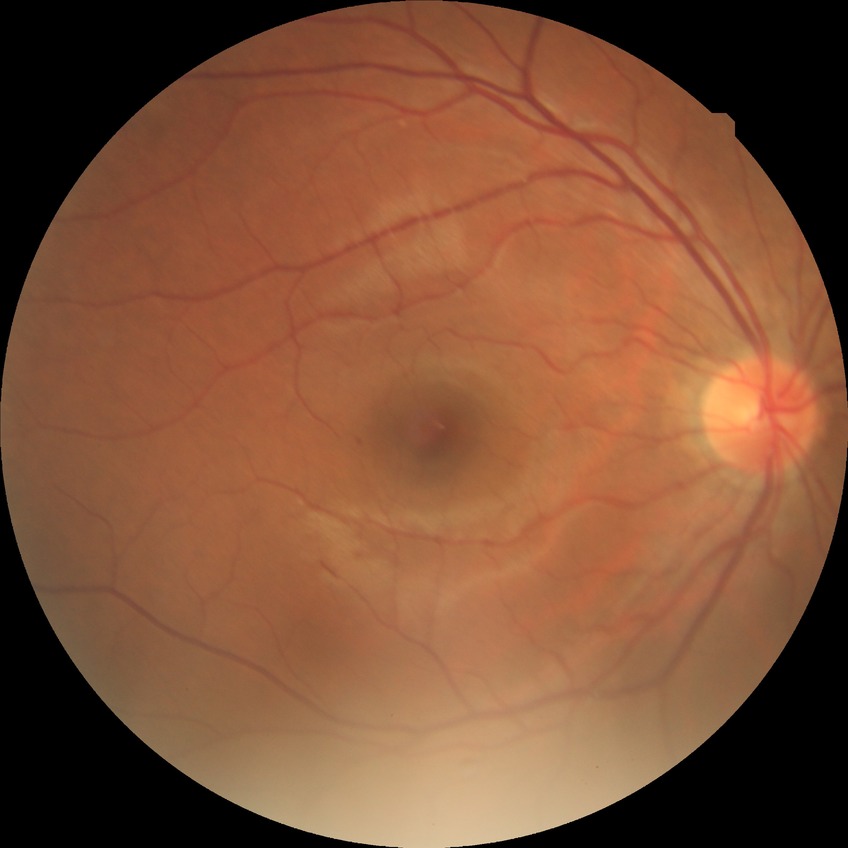
DR class=non-proliferative diabetic retinopathy, Davis grading=simple diabetic retinopathy.